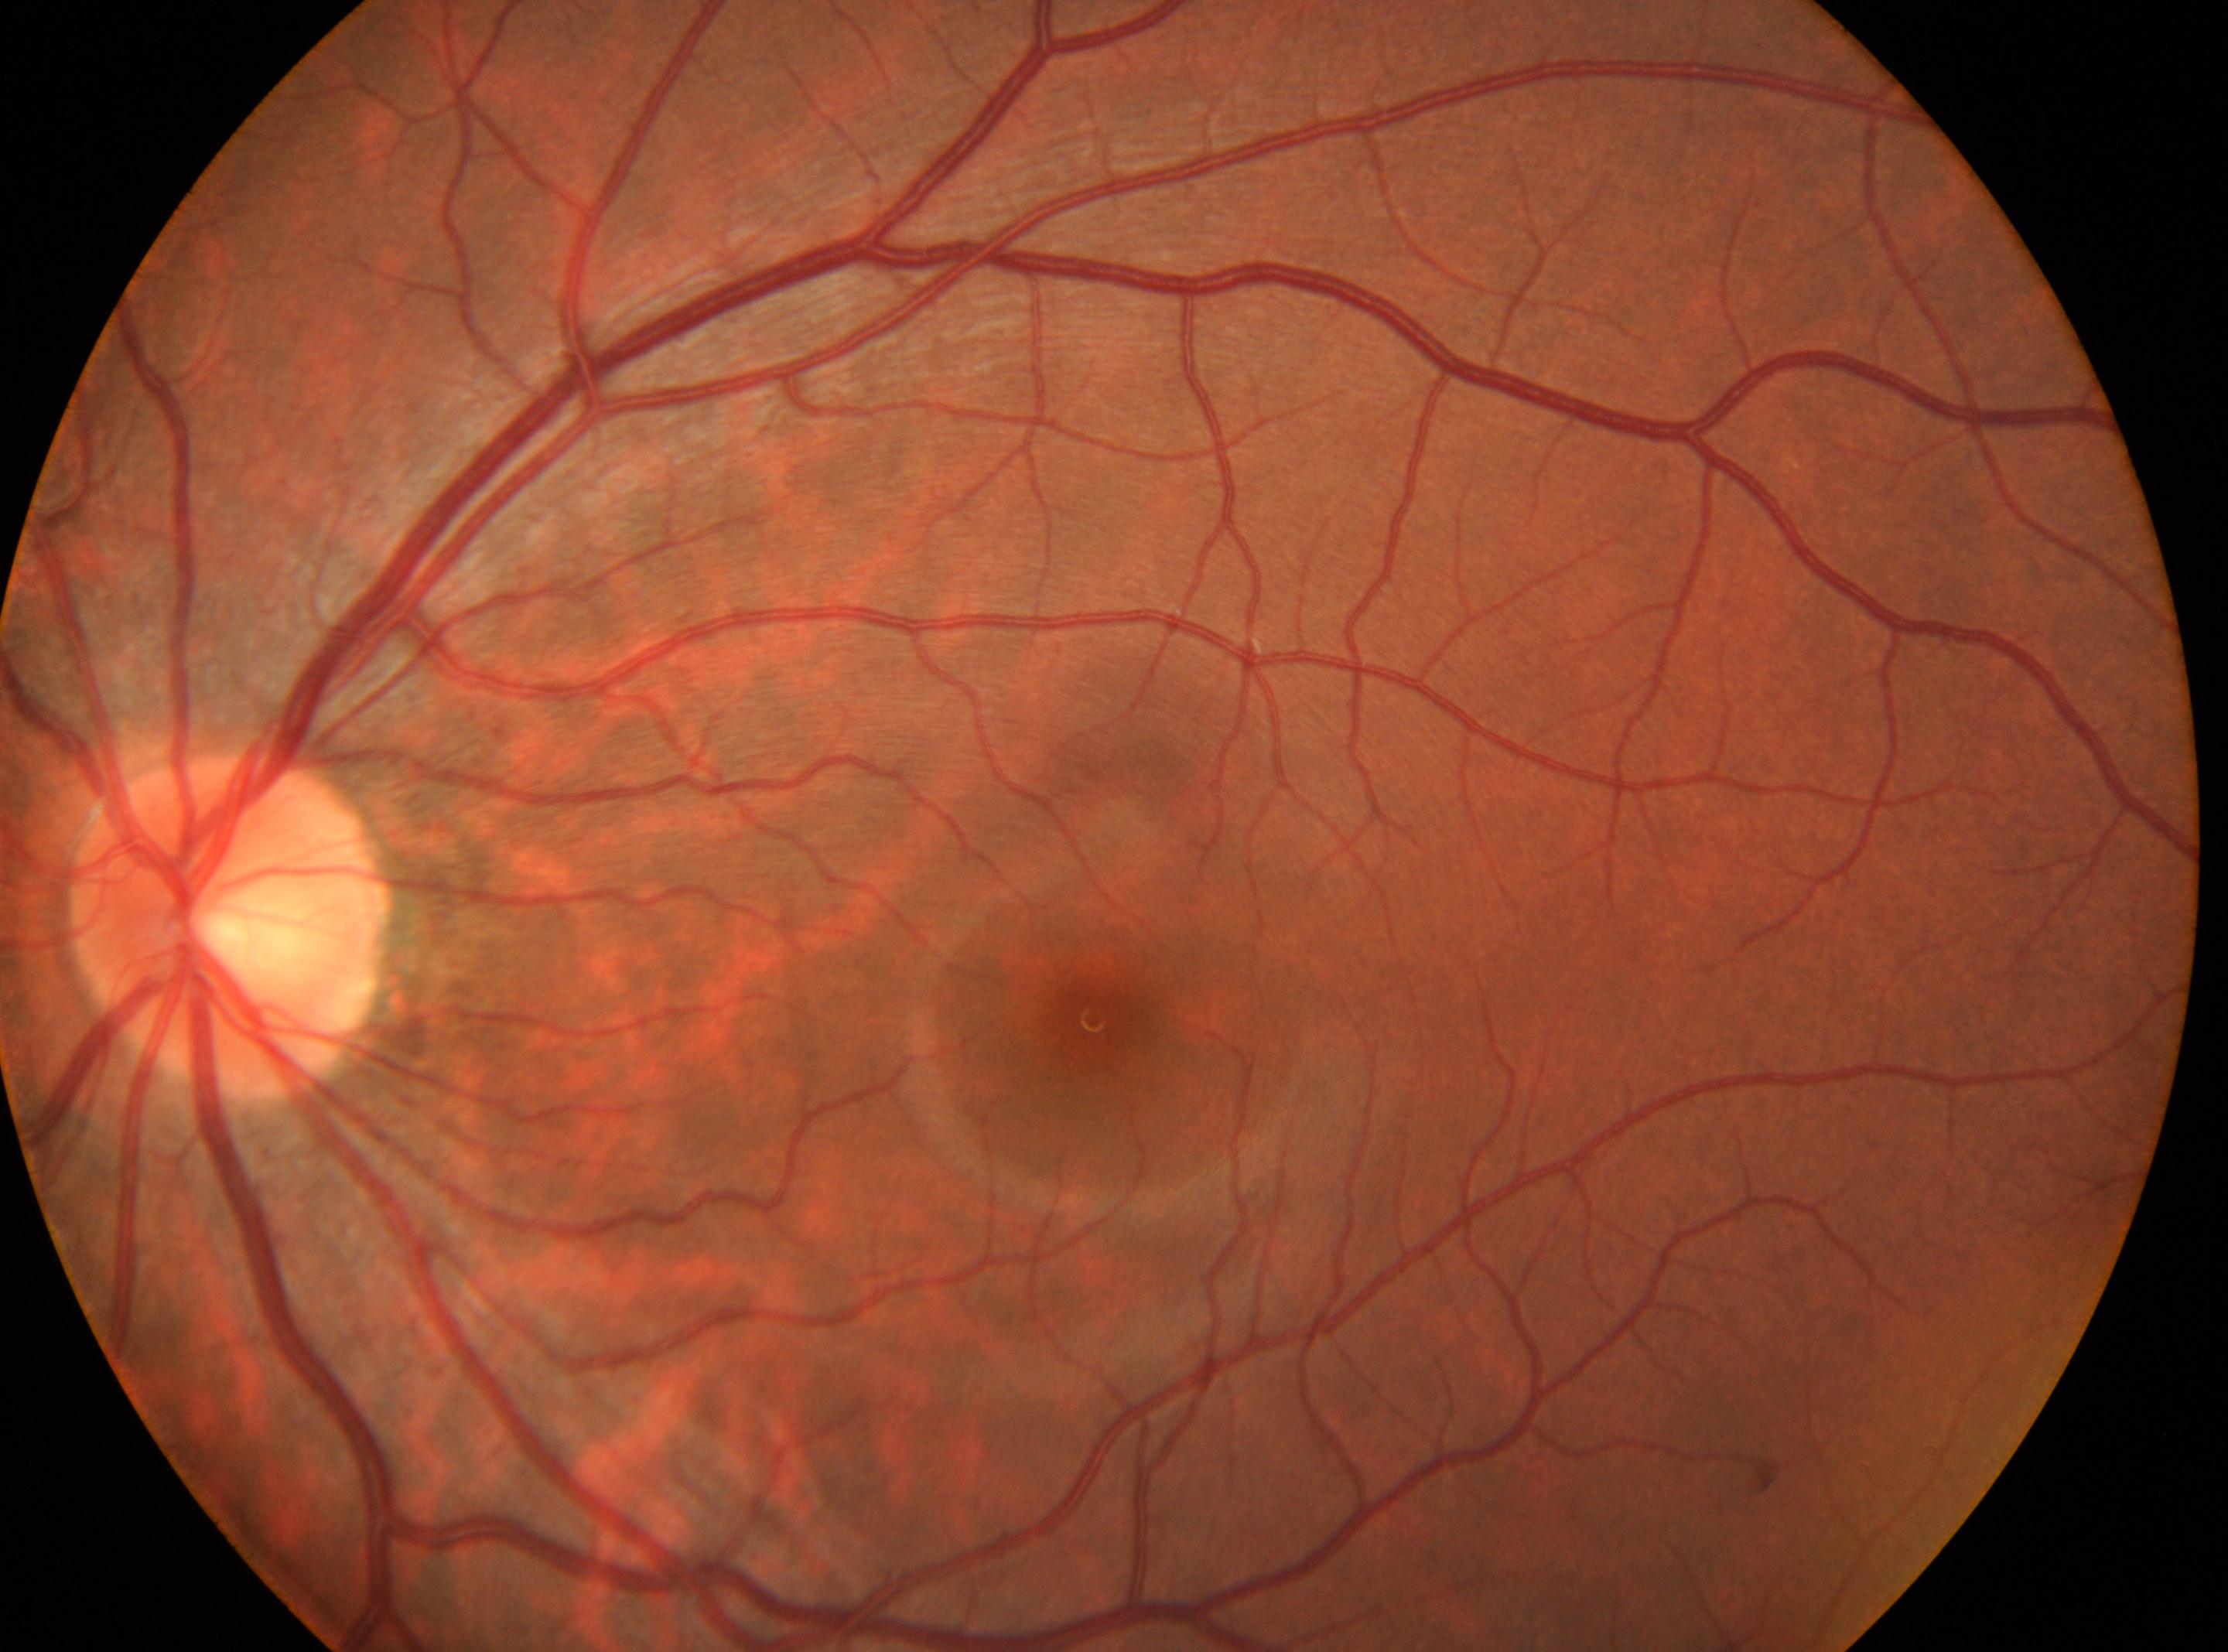

Imaged eye: the left eye.
DR is 0/4.
Disc center located at x=231, y=927.
The fovea centralis is at x=1094, y=1019.